Image size 640x480. Infant wide-field fundus photograph
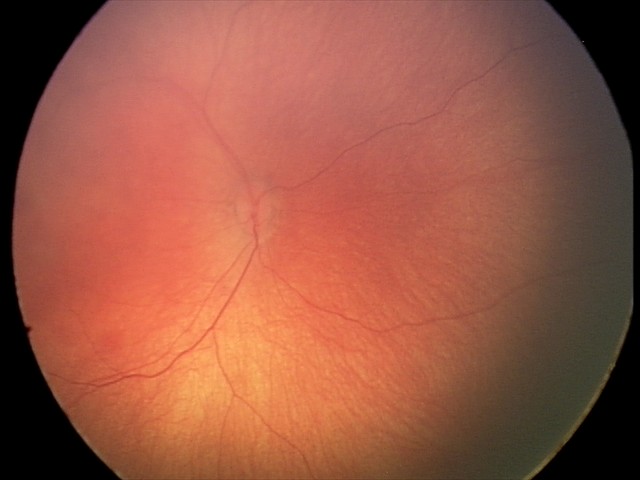 Screening examination consistent with retinal hemorrhages.